Color fundus image — 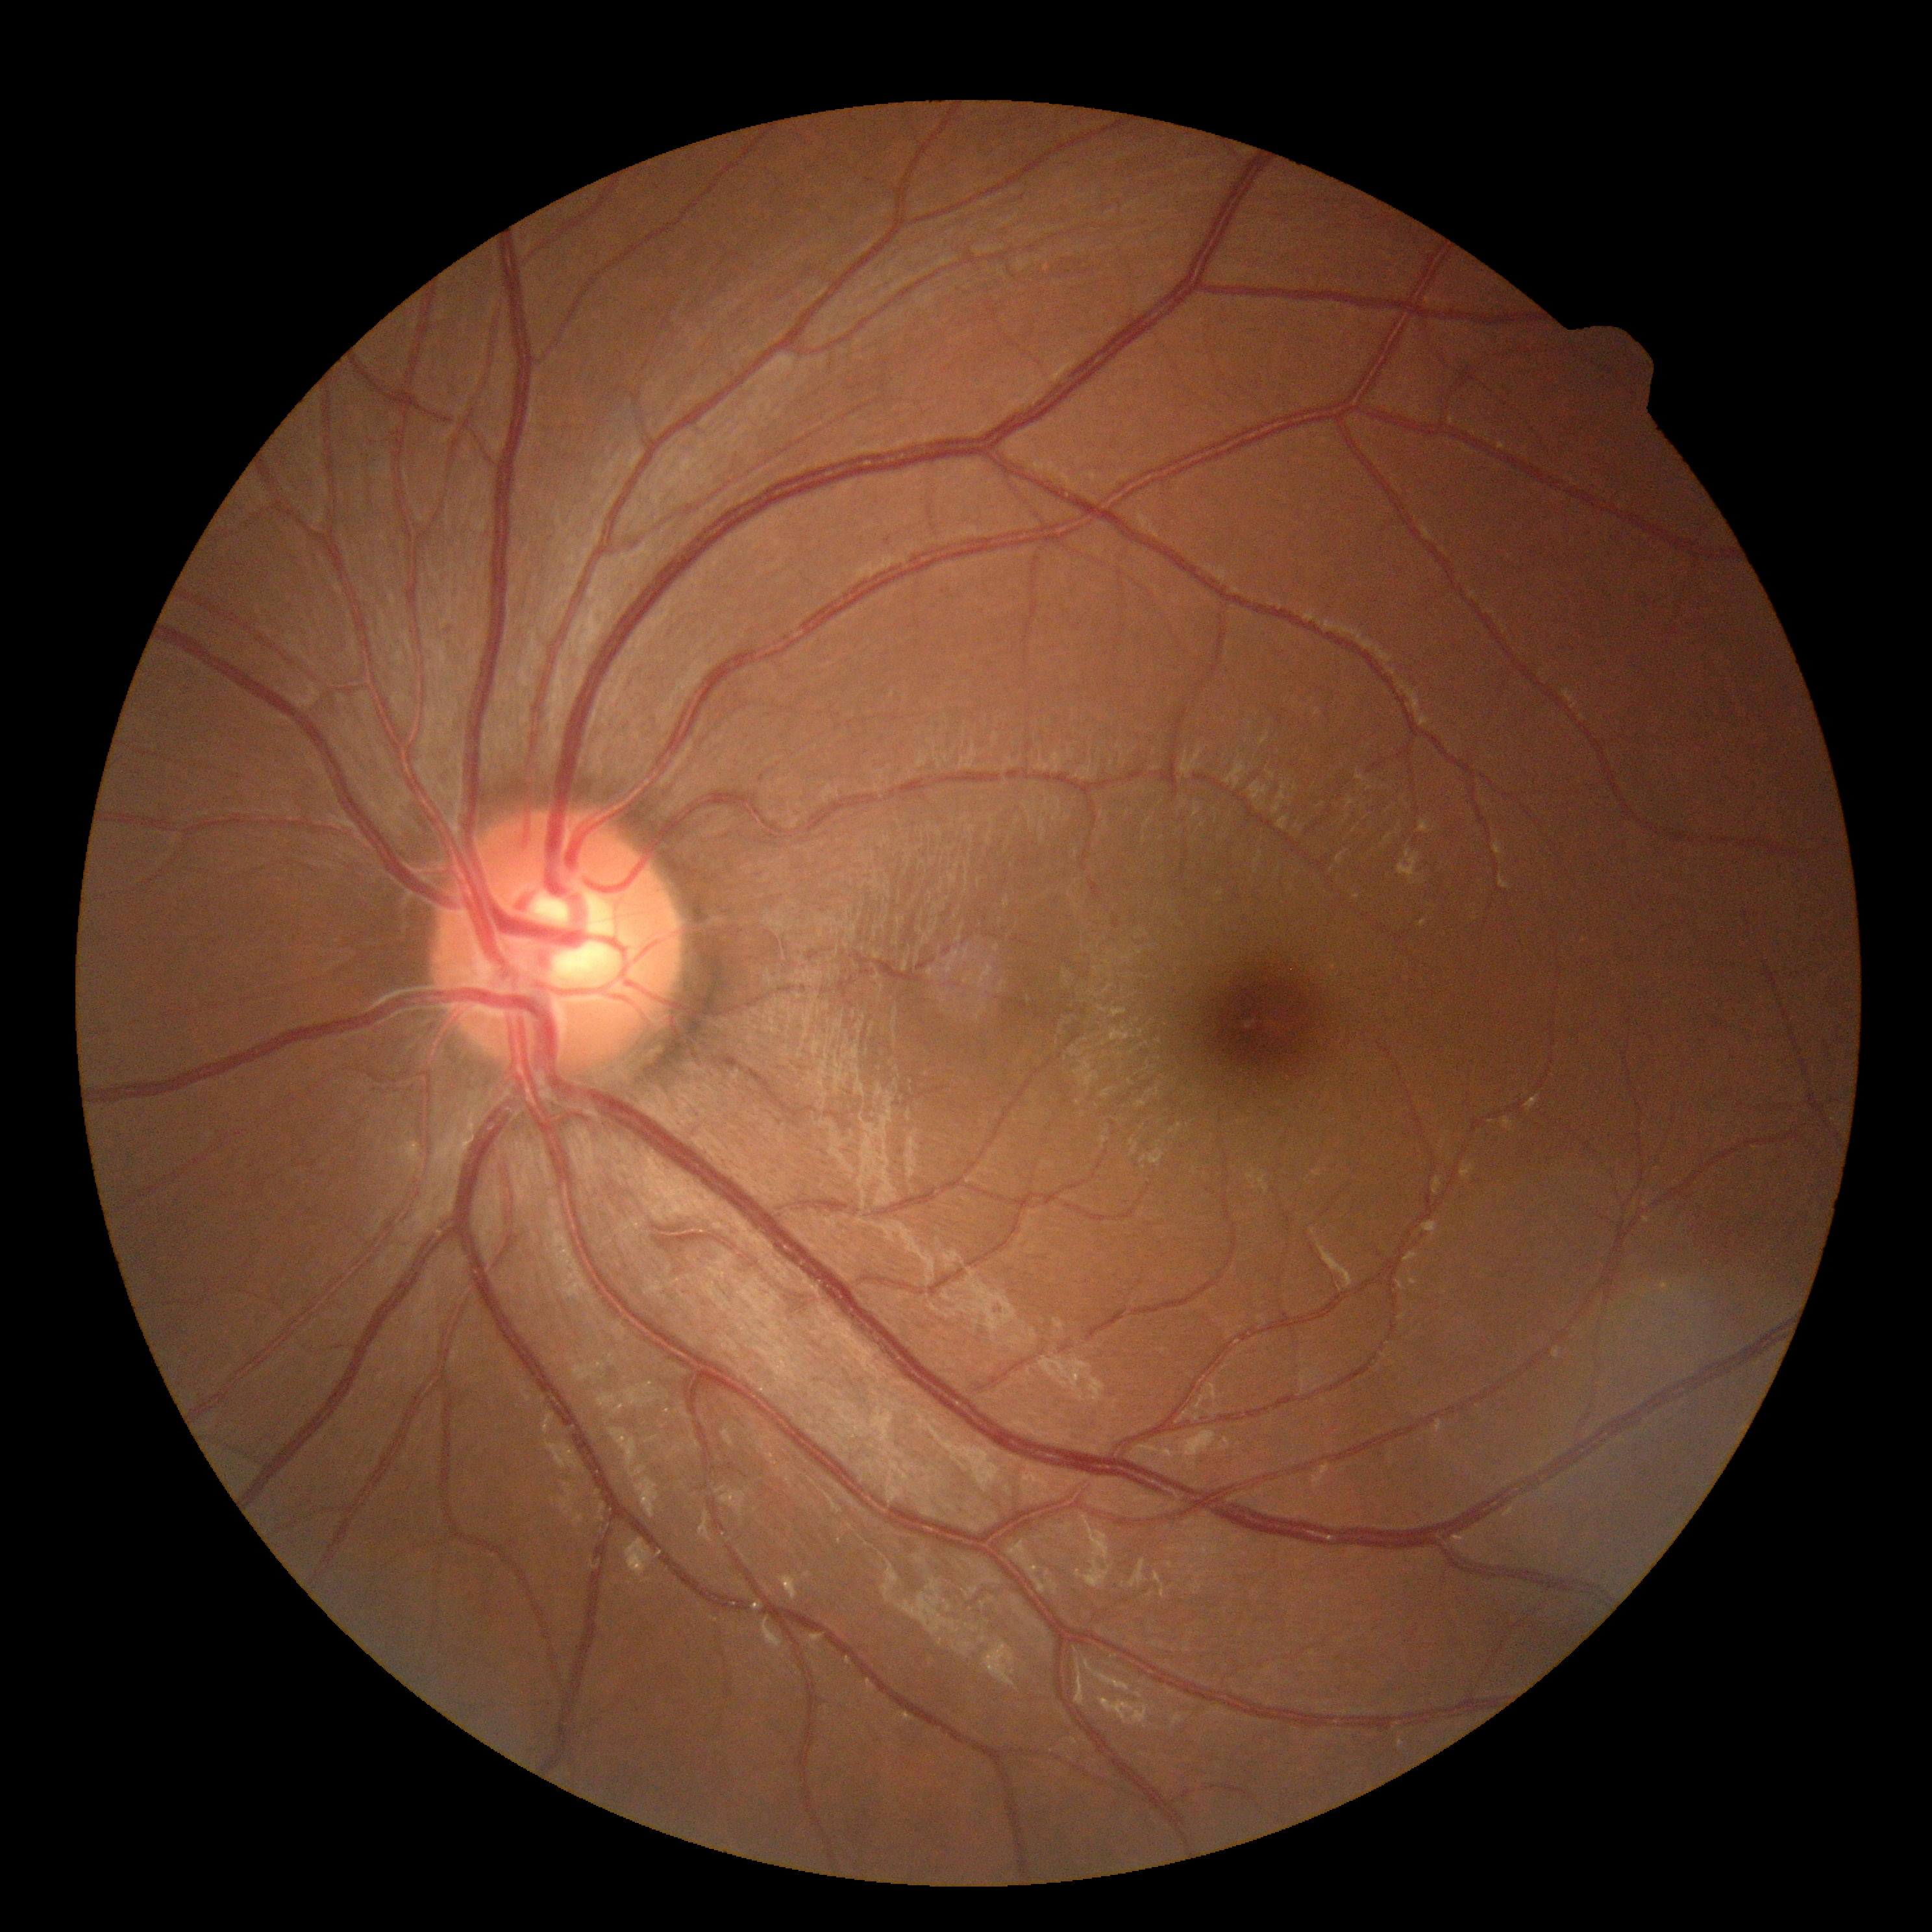 DR grade is 0. No diabetic retinal disease findings.